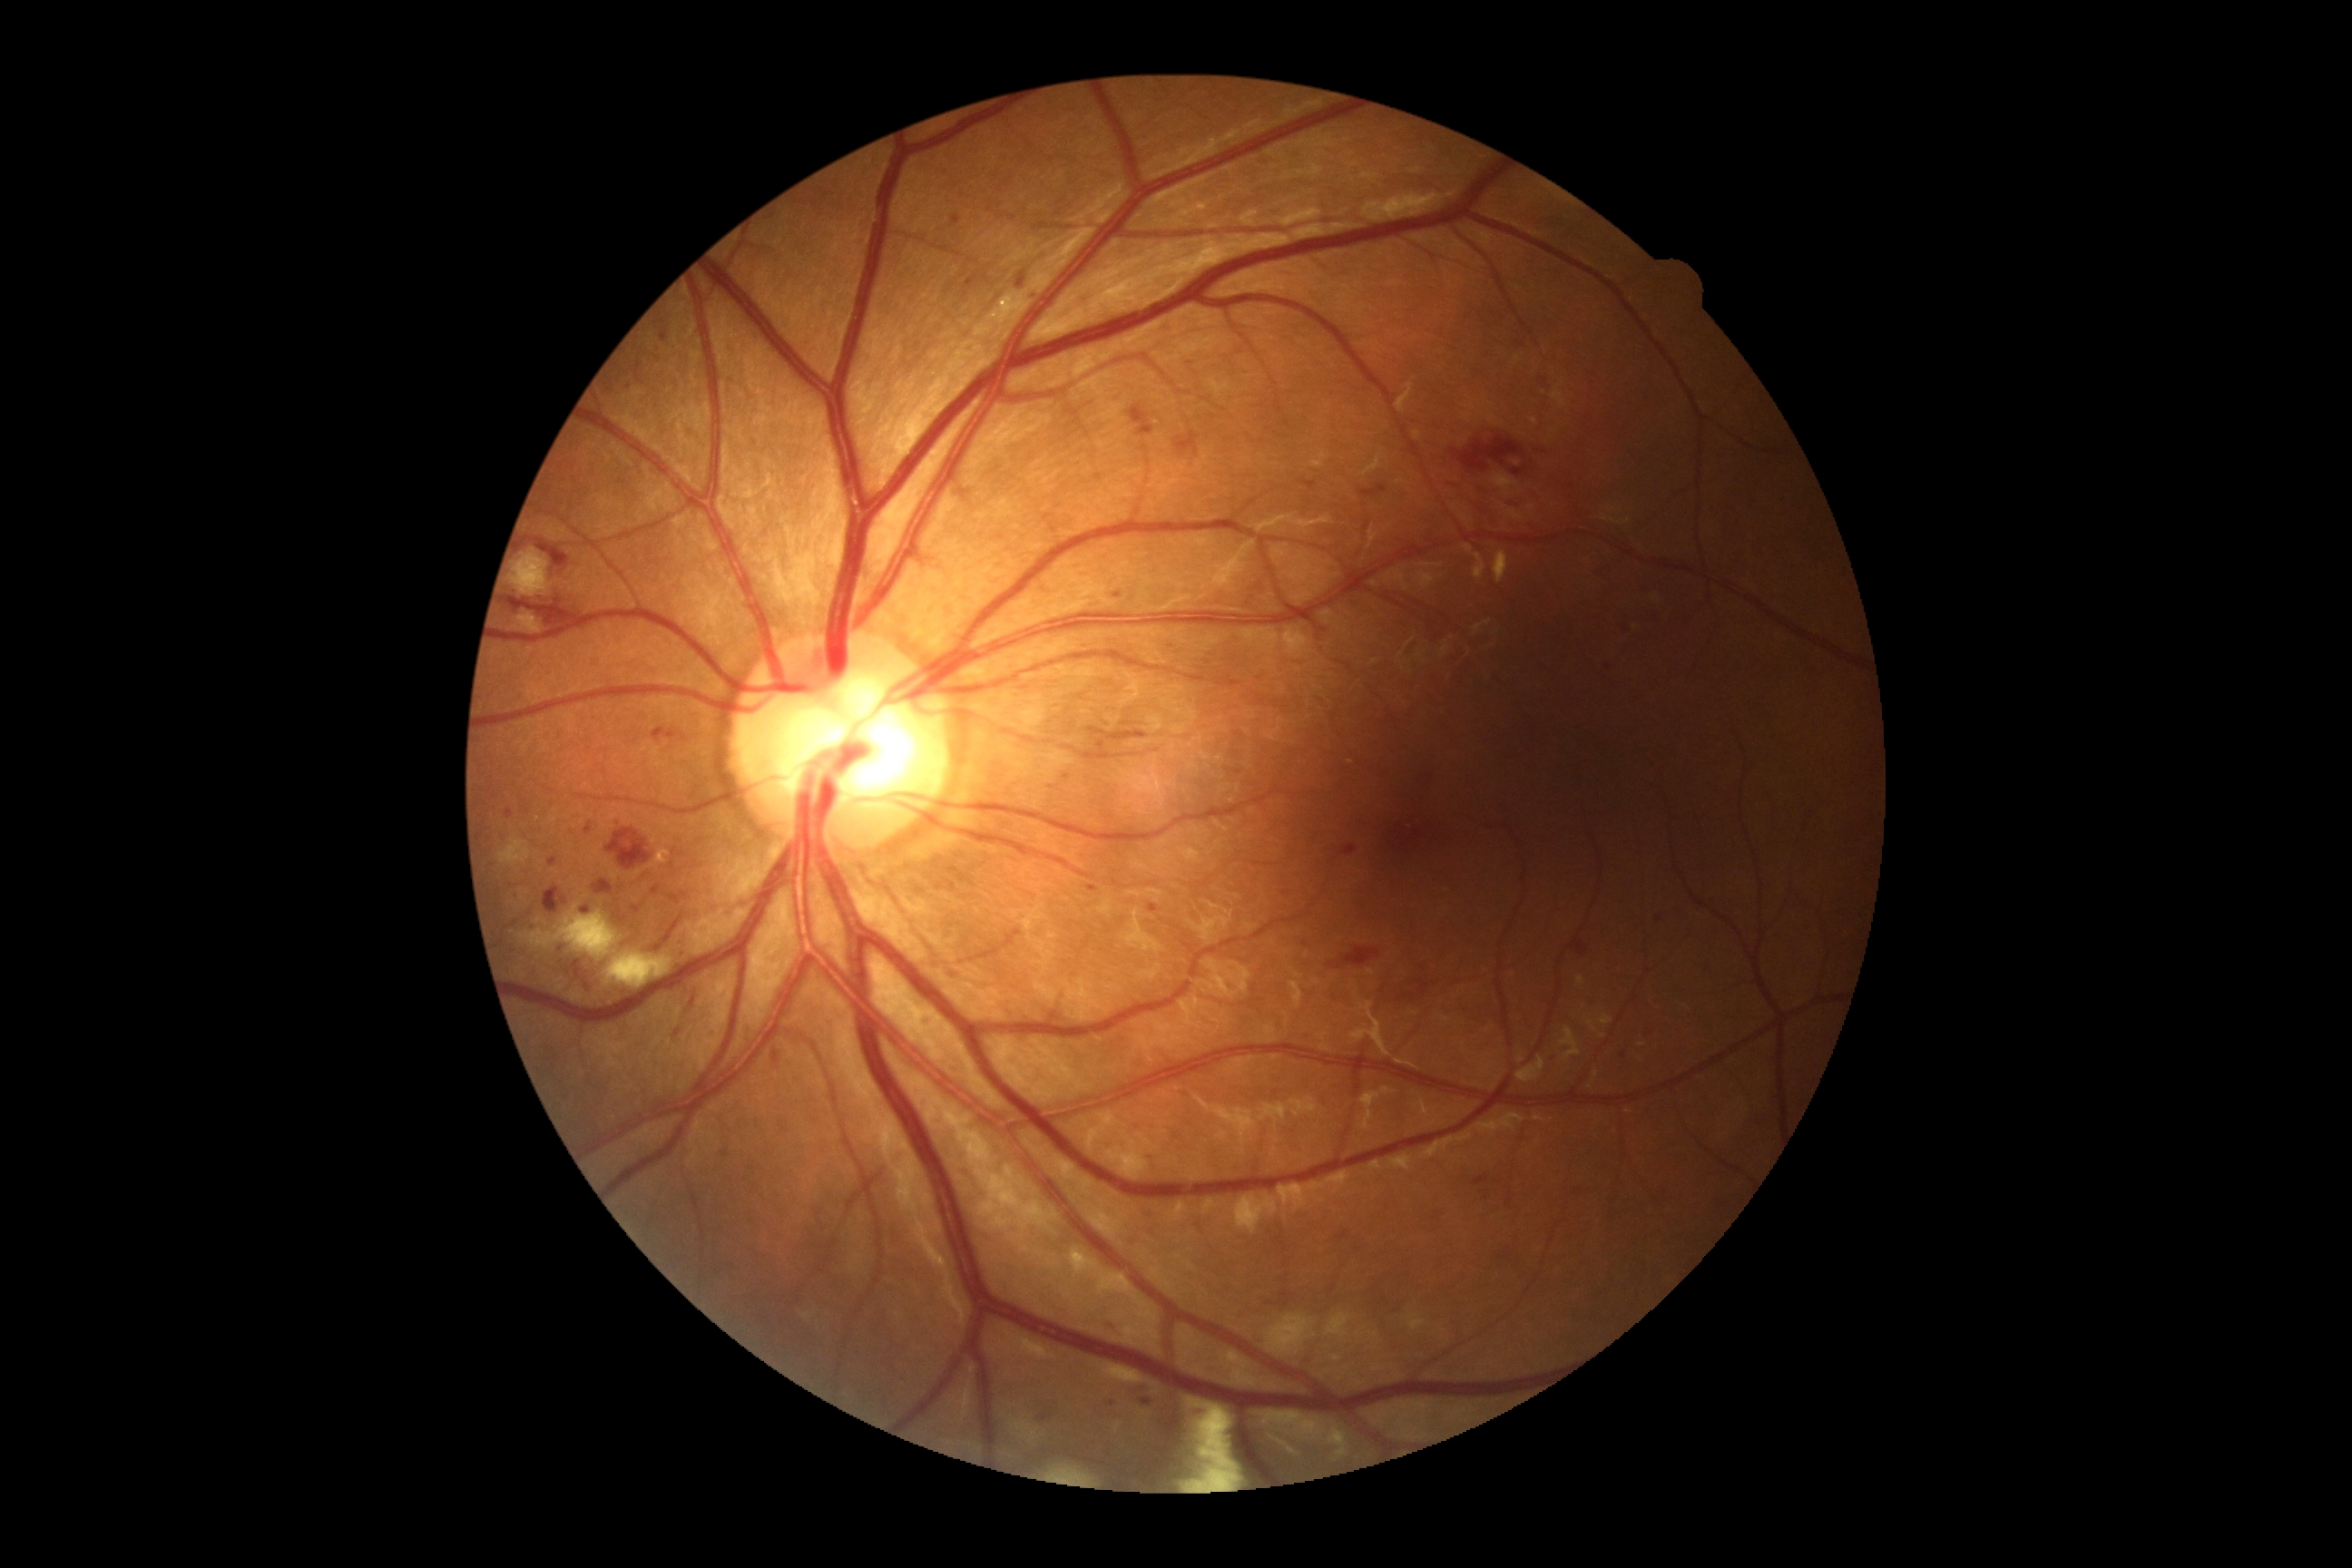 {
  "dr_grade": "grade 2 — more than just microaneurysms but less than severe NPDR"
}